848 by 848 pixels; camera: NIDEK AFC-230; nonmydriatic; DR severity per modified Davis staging; 45-degree field of view; CFP
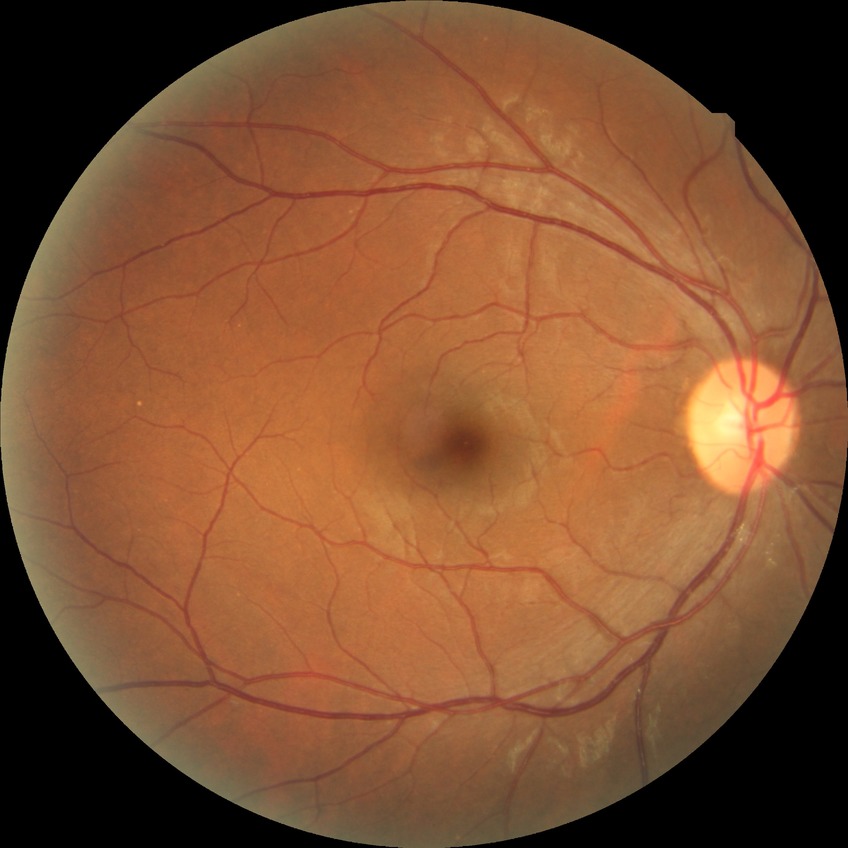 Davis grading: no diabetic retinopathy.